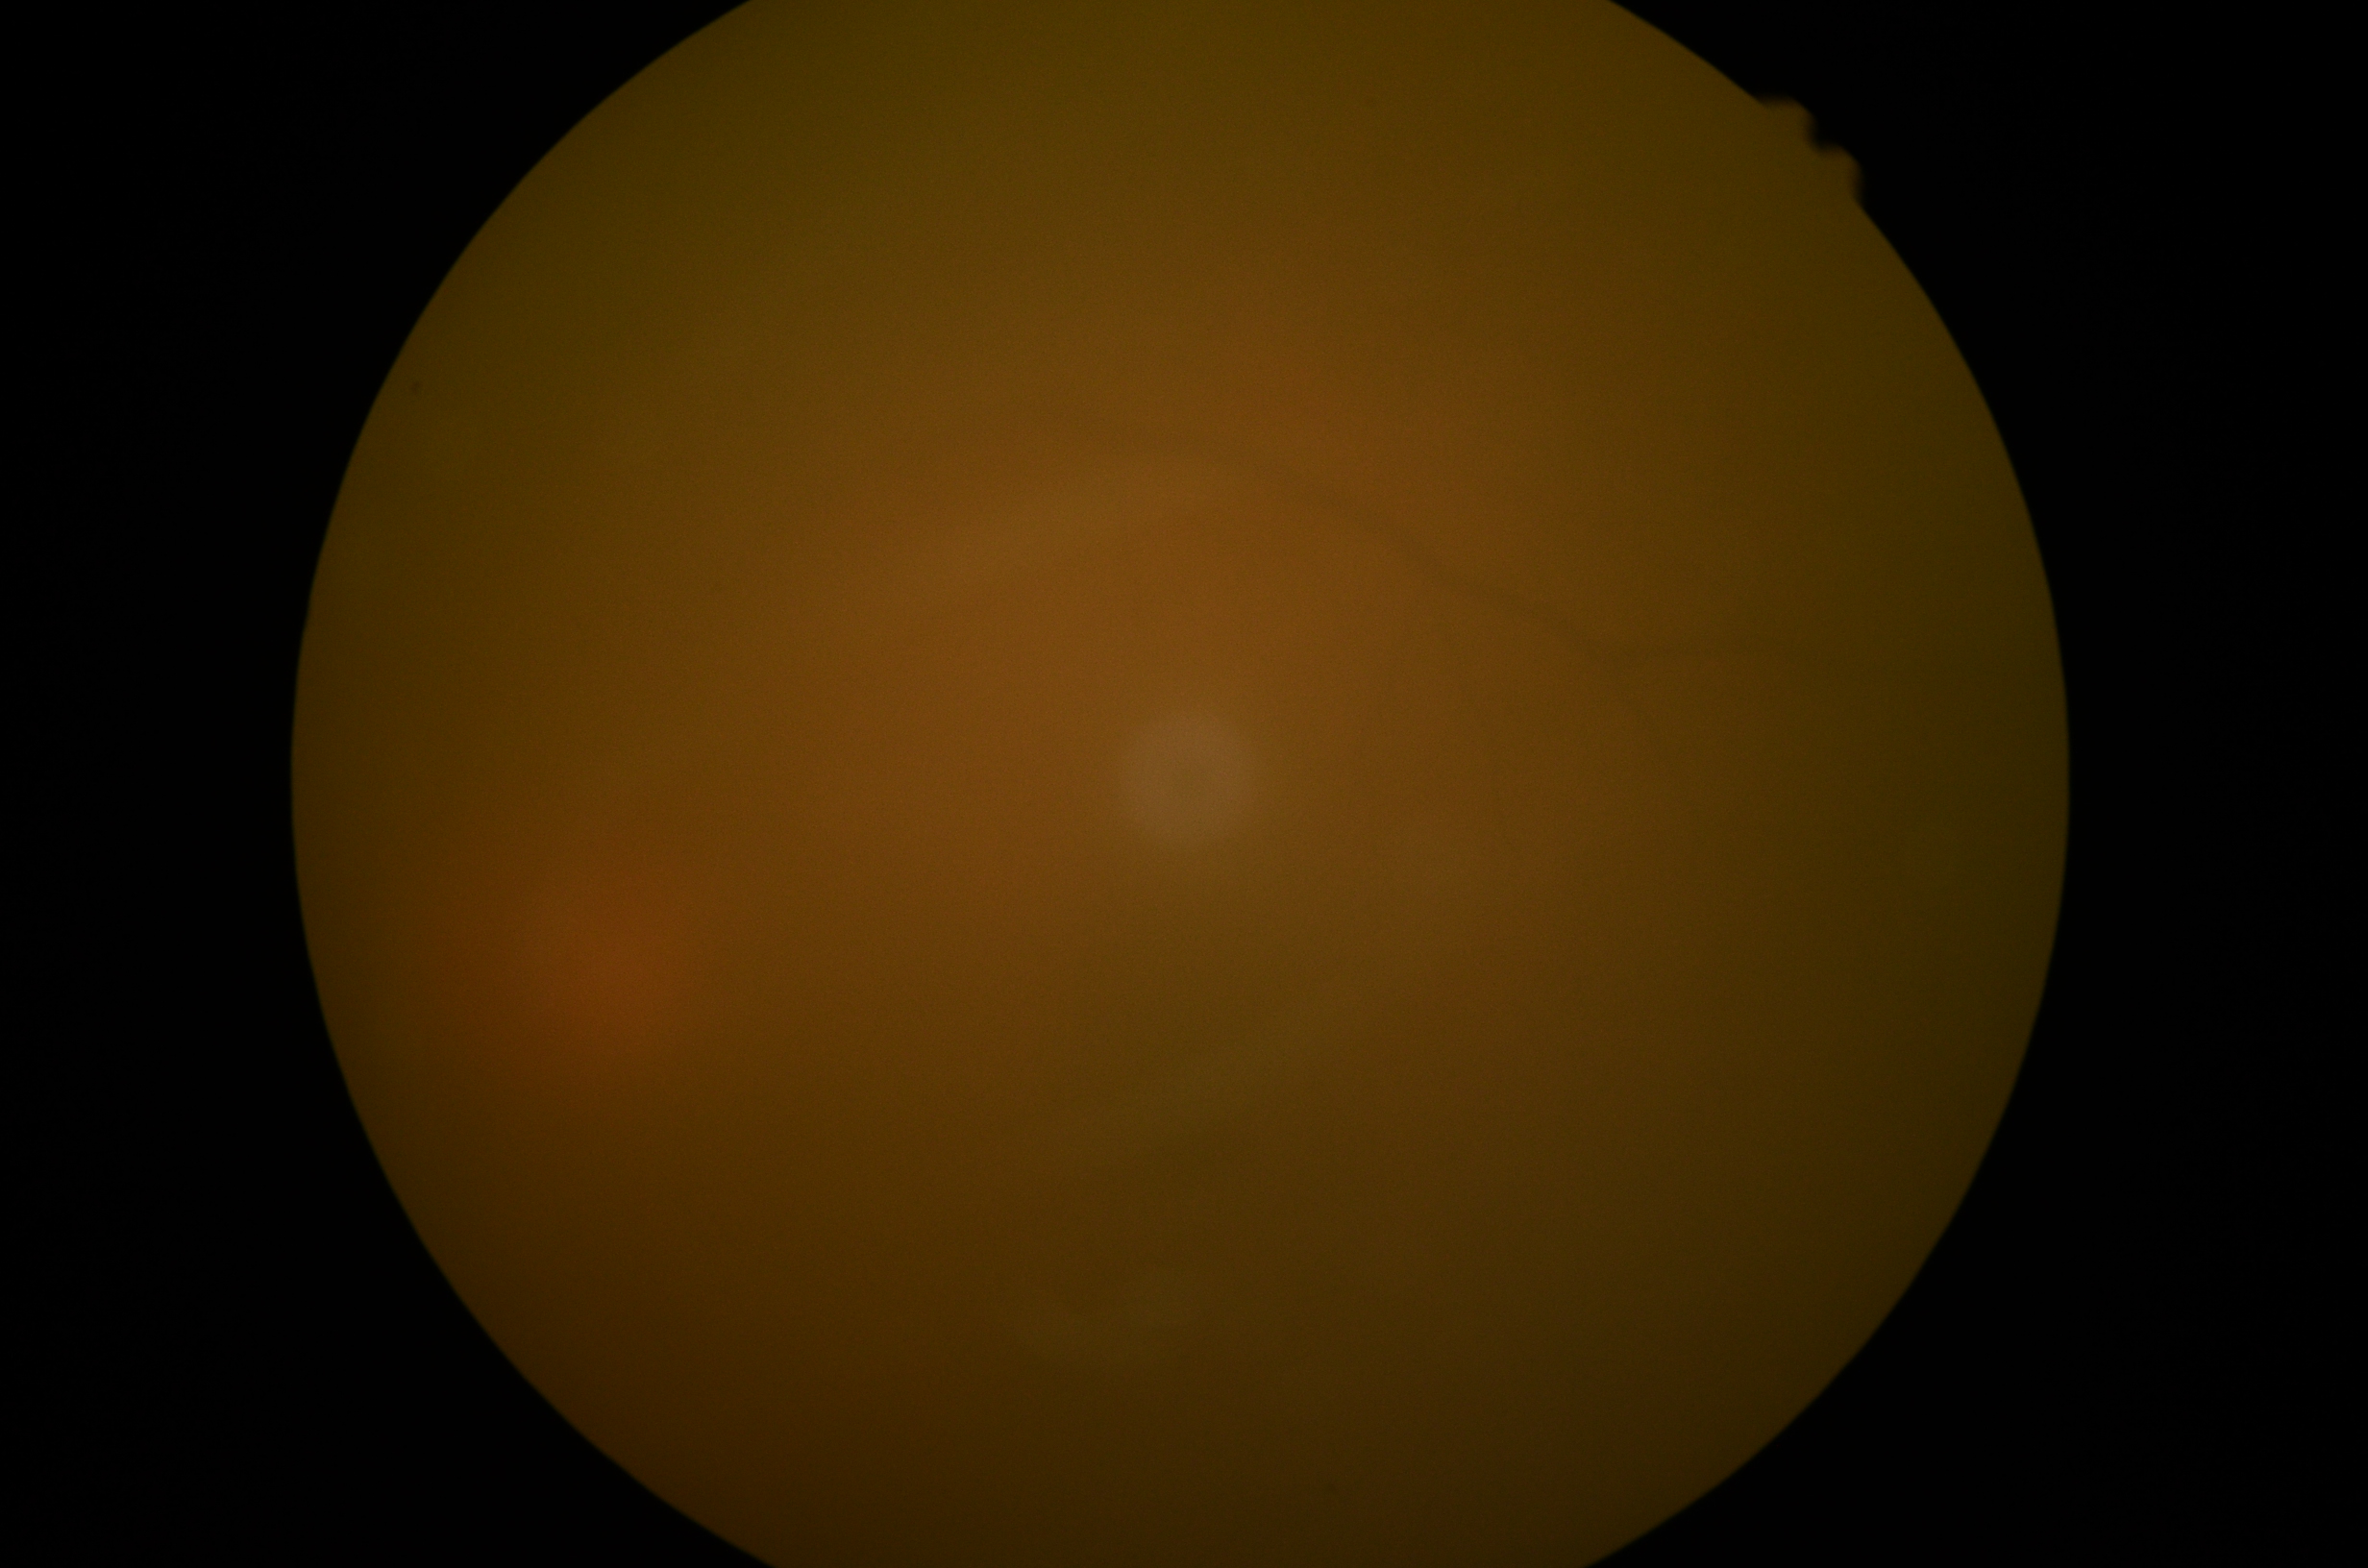
diabetic retinopathy (DR)@ungradable due to poor image quality.